FOV: 45 degrees. Image size 2352x1568
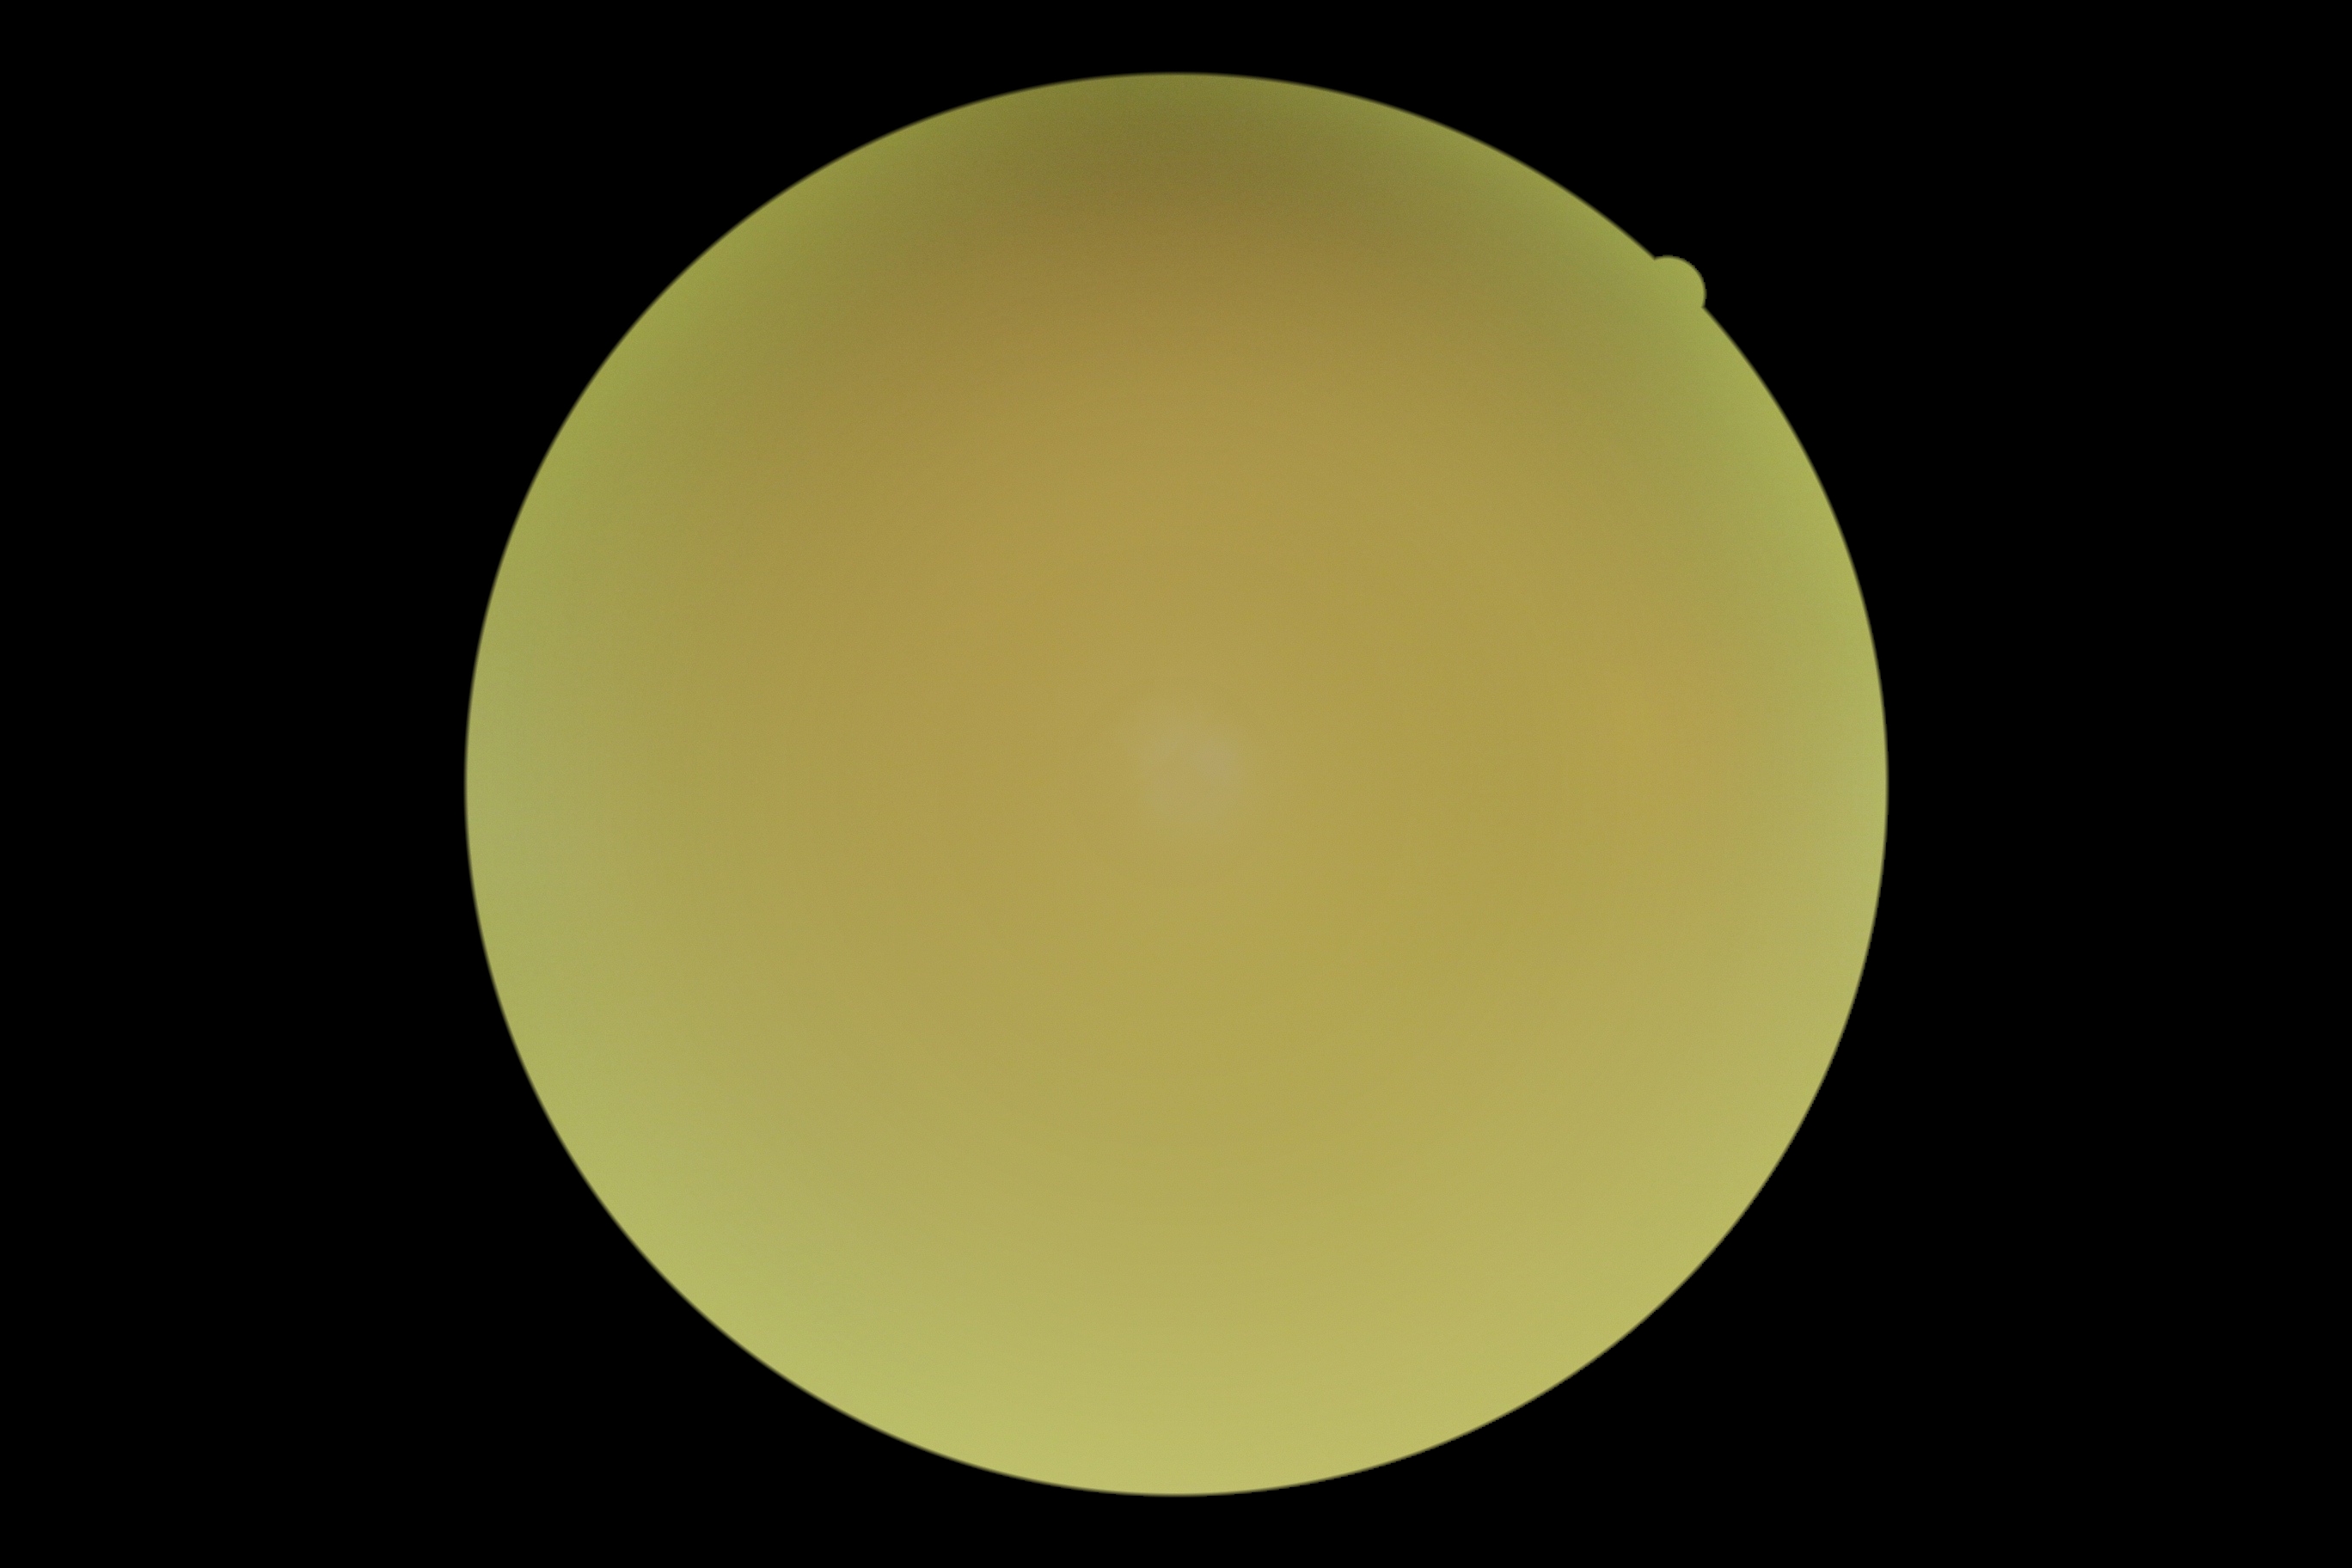 • image quality — too poor for DR grading
• DR grade — ungradable